Camera: Natus RetCam Envision (130° FOV) · 1440 by 1080 pixels · infant wide-field fundus photograph: 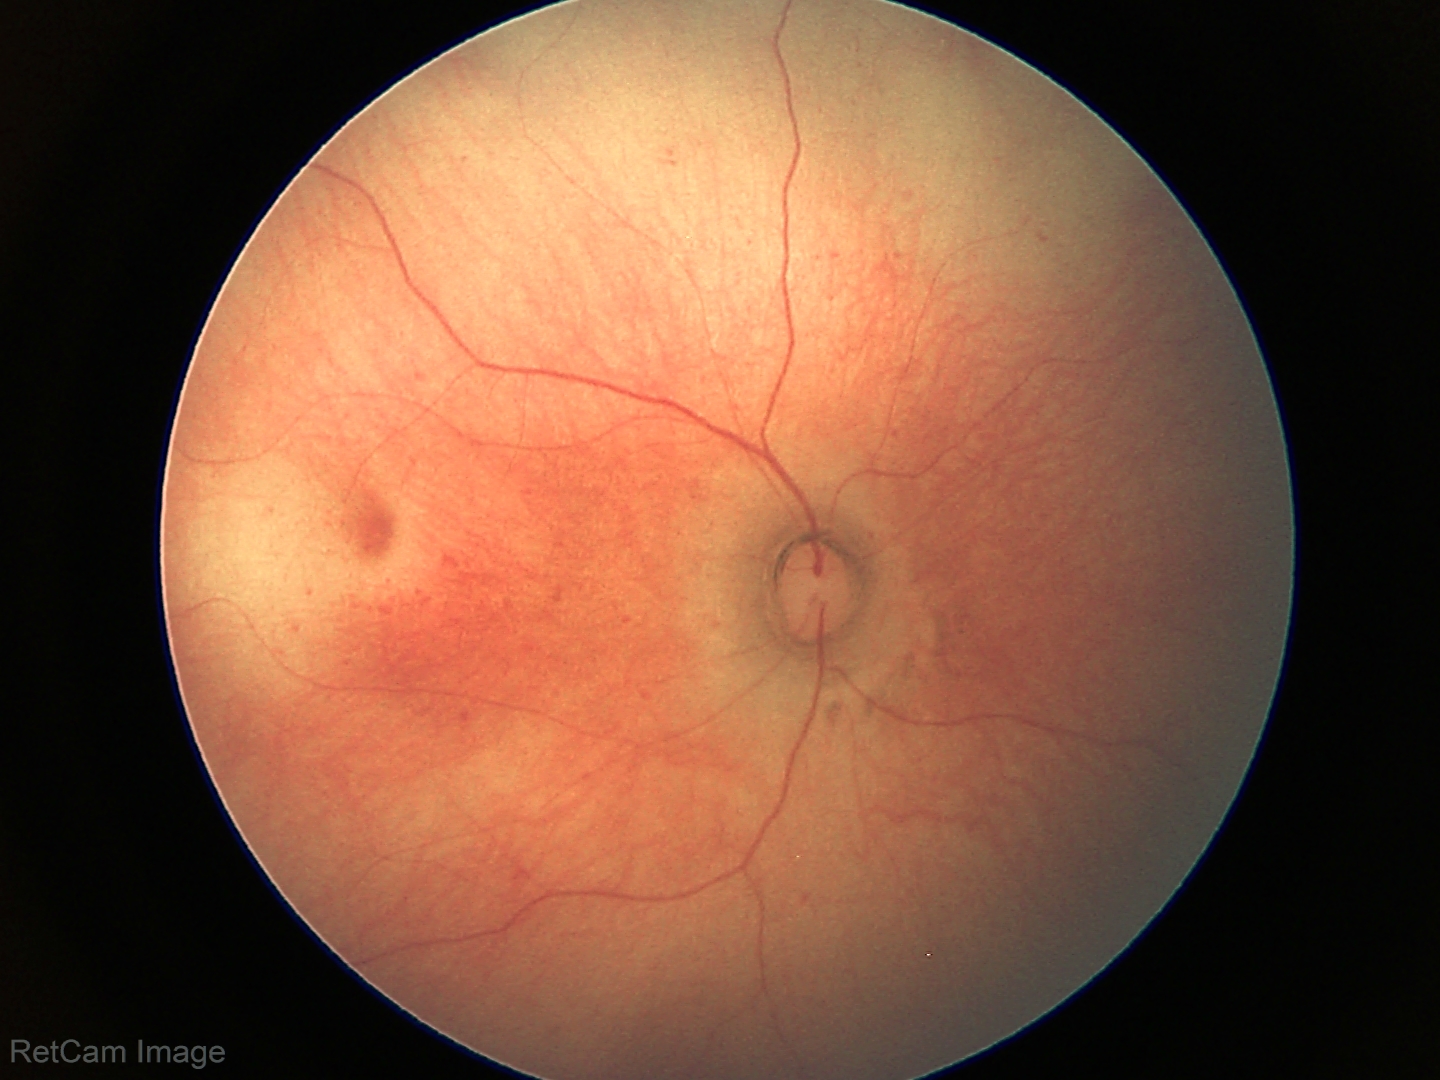 Diagnosis = normal retinal appearance.